Color fundus image — 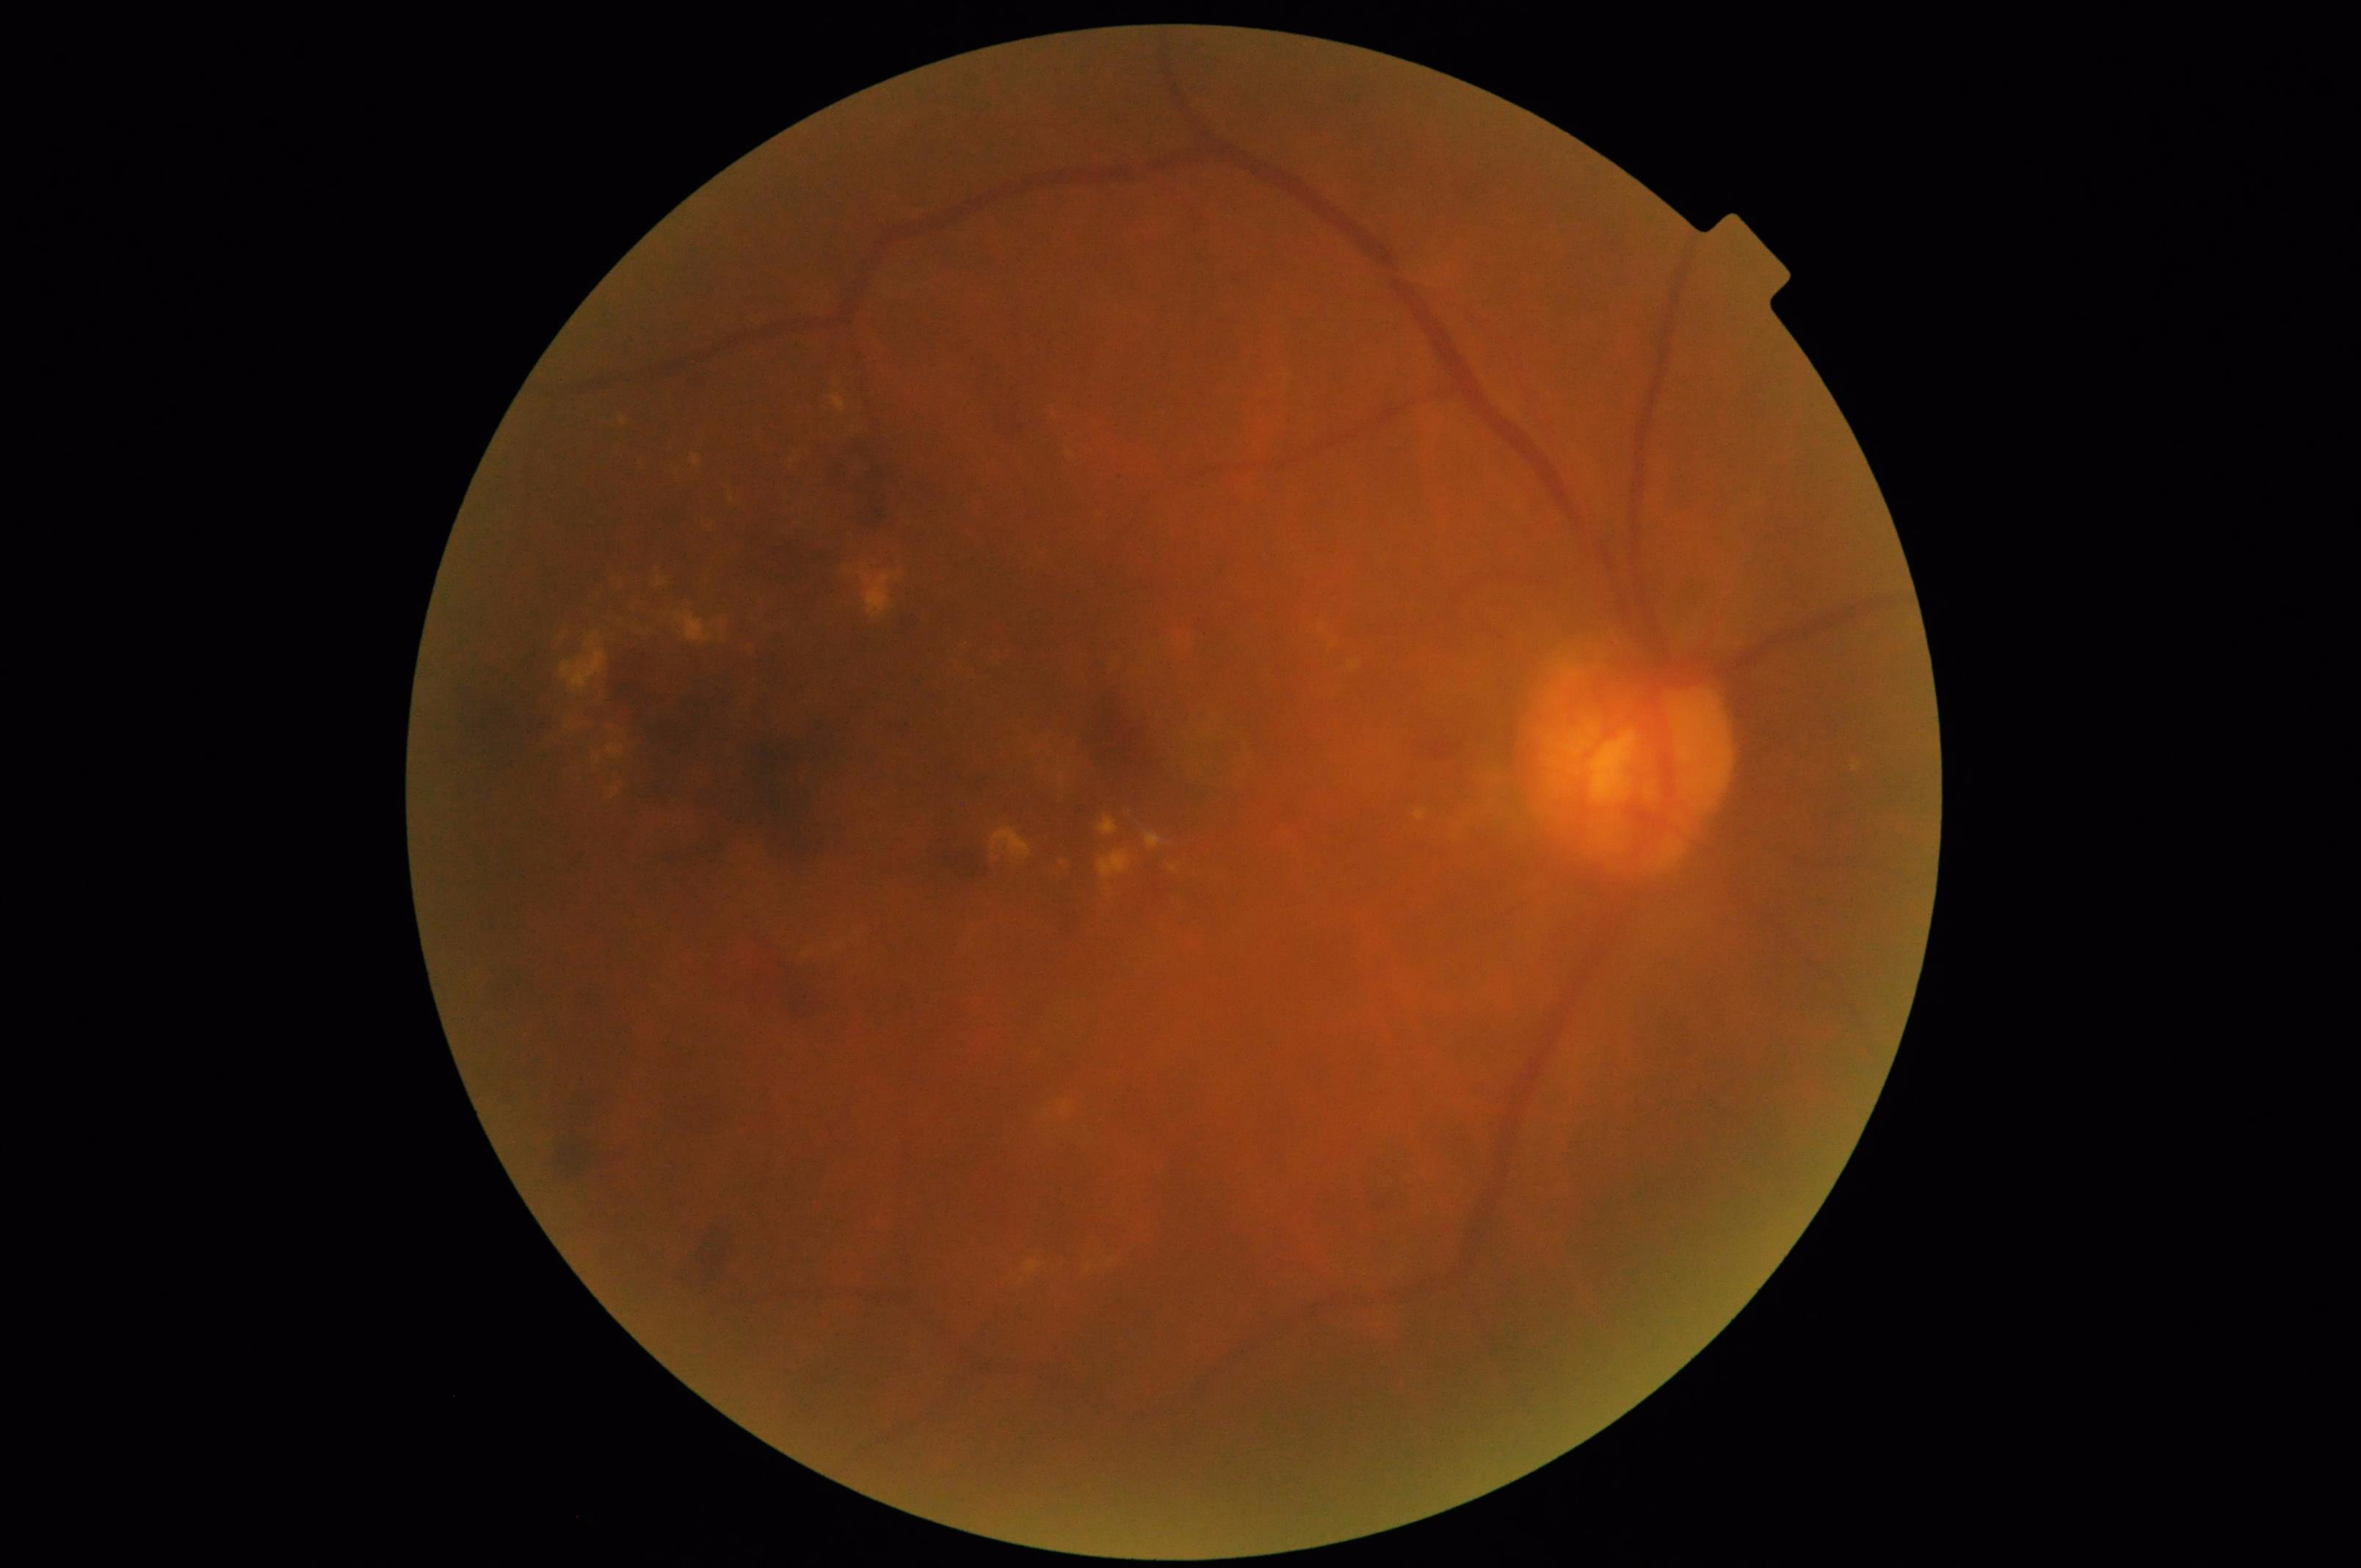 Adequate contrast for distinguishing structures. Overall image quality is poor. Illumination and color are suboptimal.